640 x 480 pixels. Wide-field fundus photograph from neonatal ROP screening — 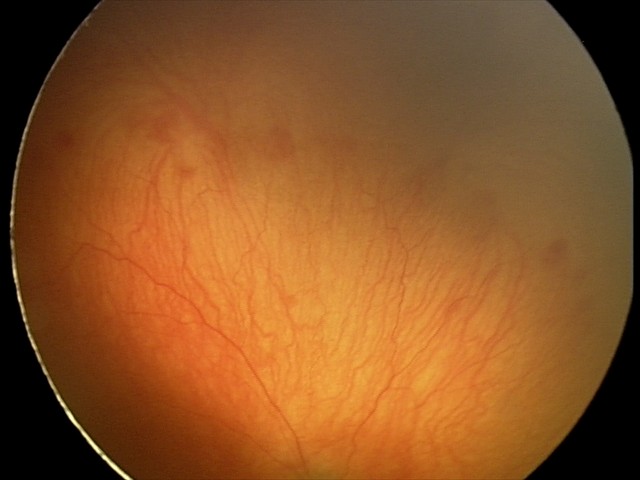

Screening series with aggressive retinopathy of prematurity.